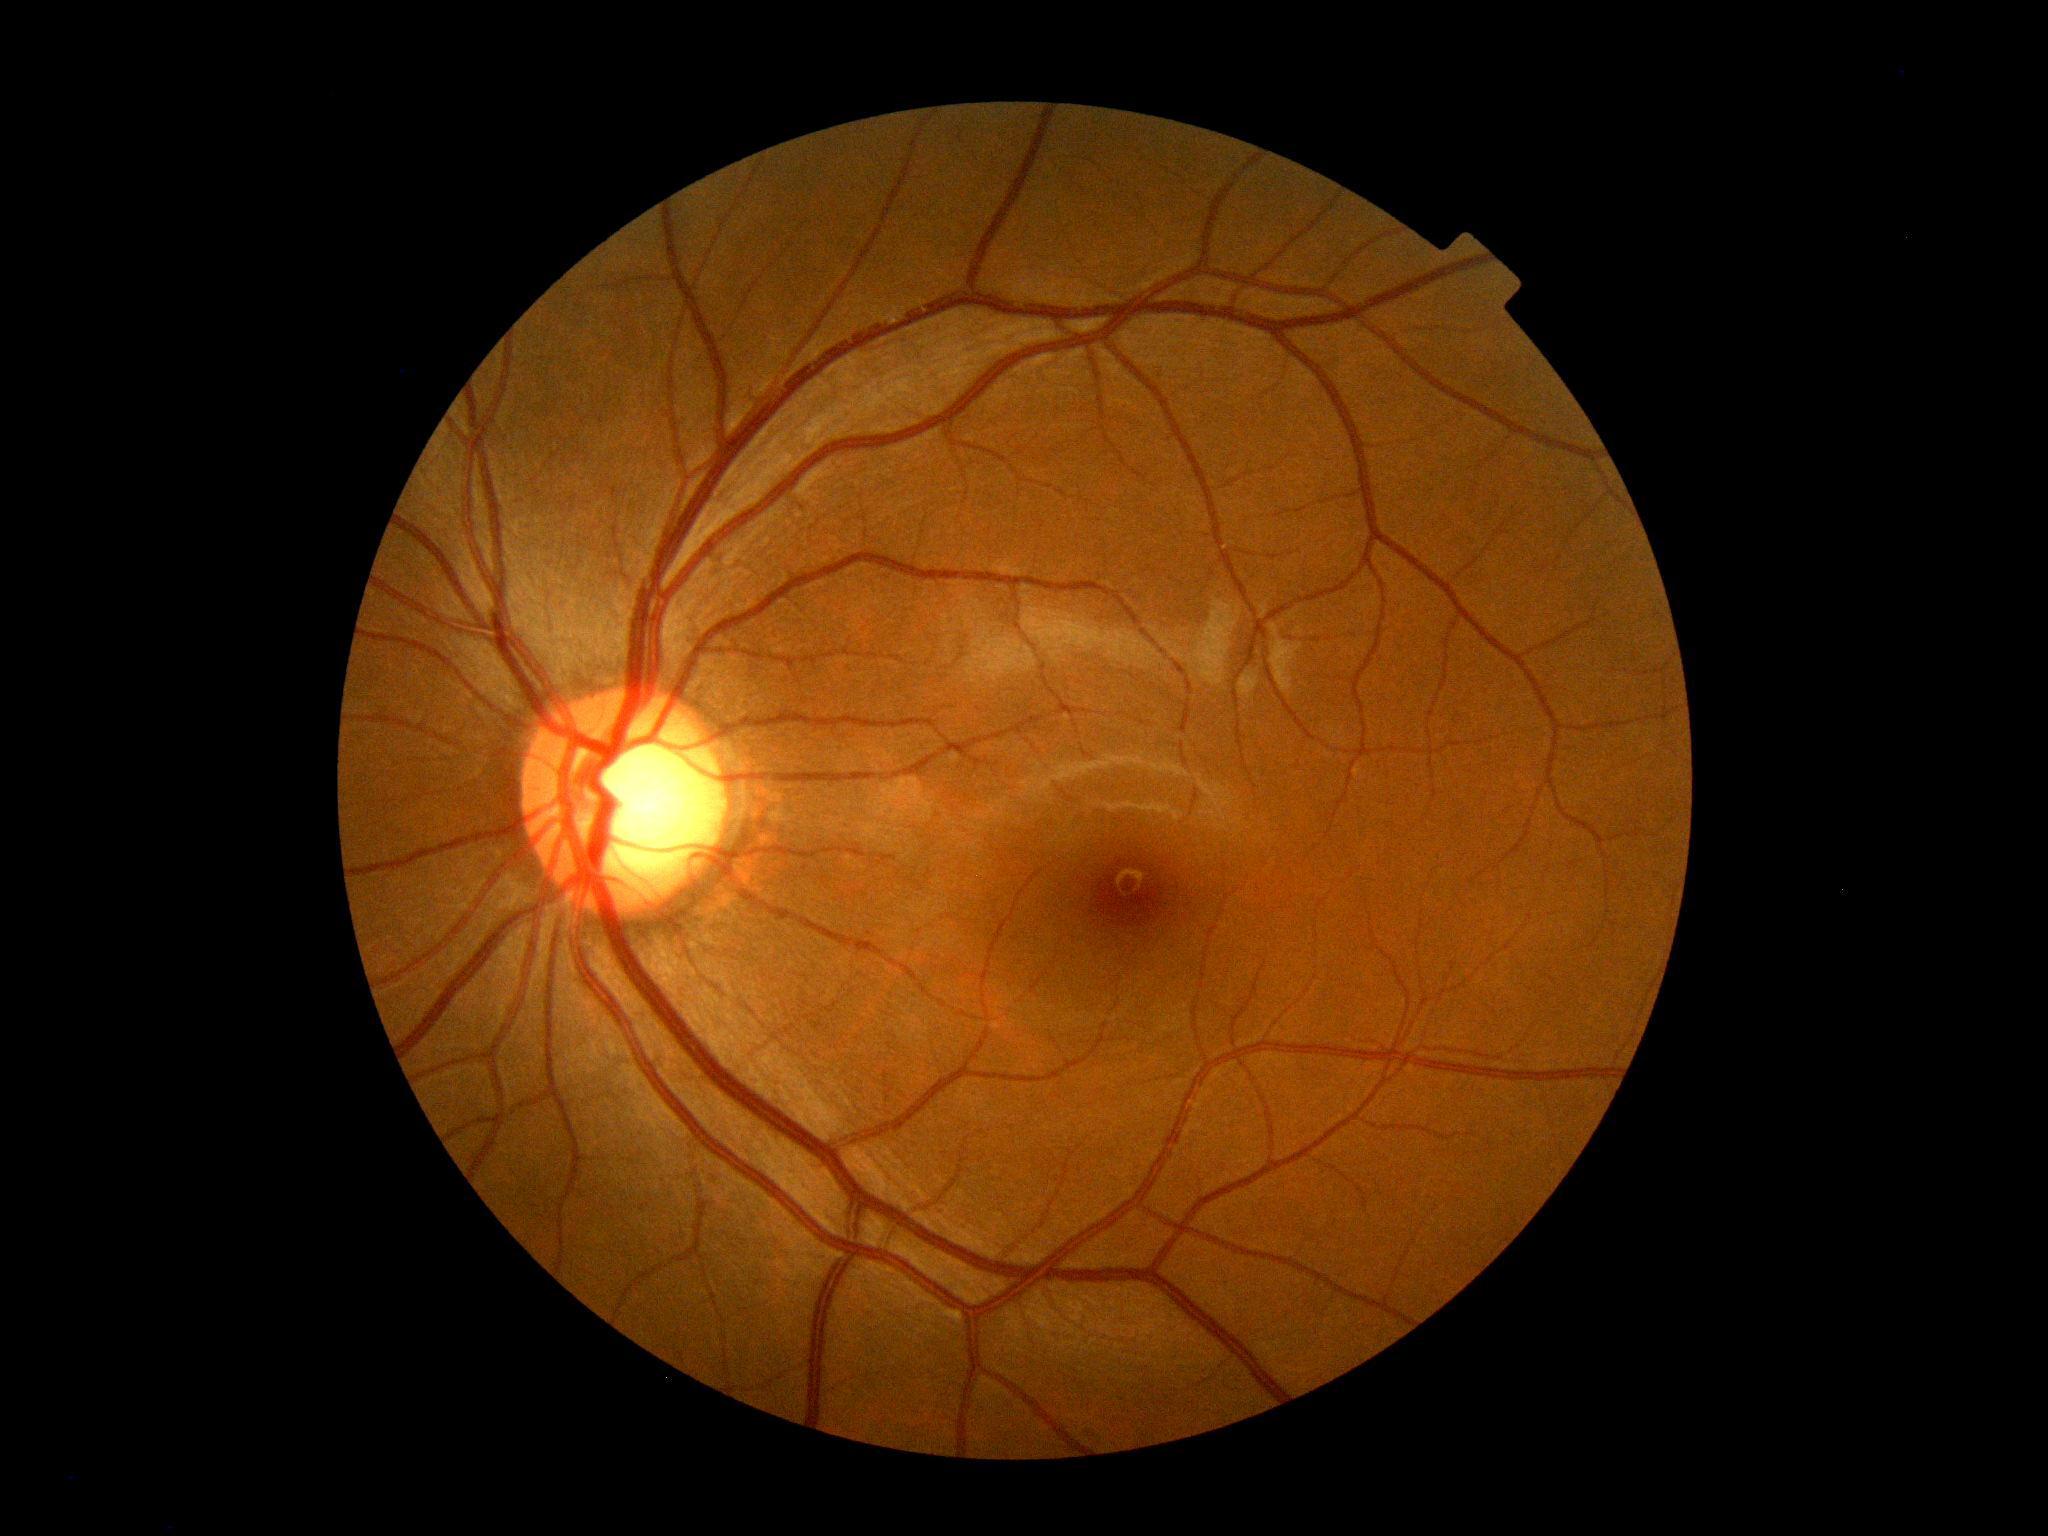

Retinopathy grade is 0.